Retinal fundus photograph — 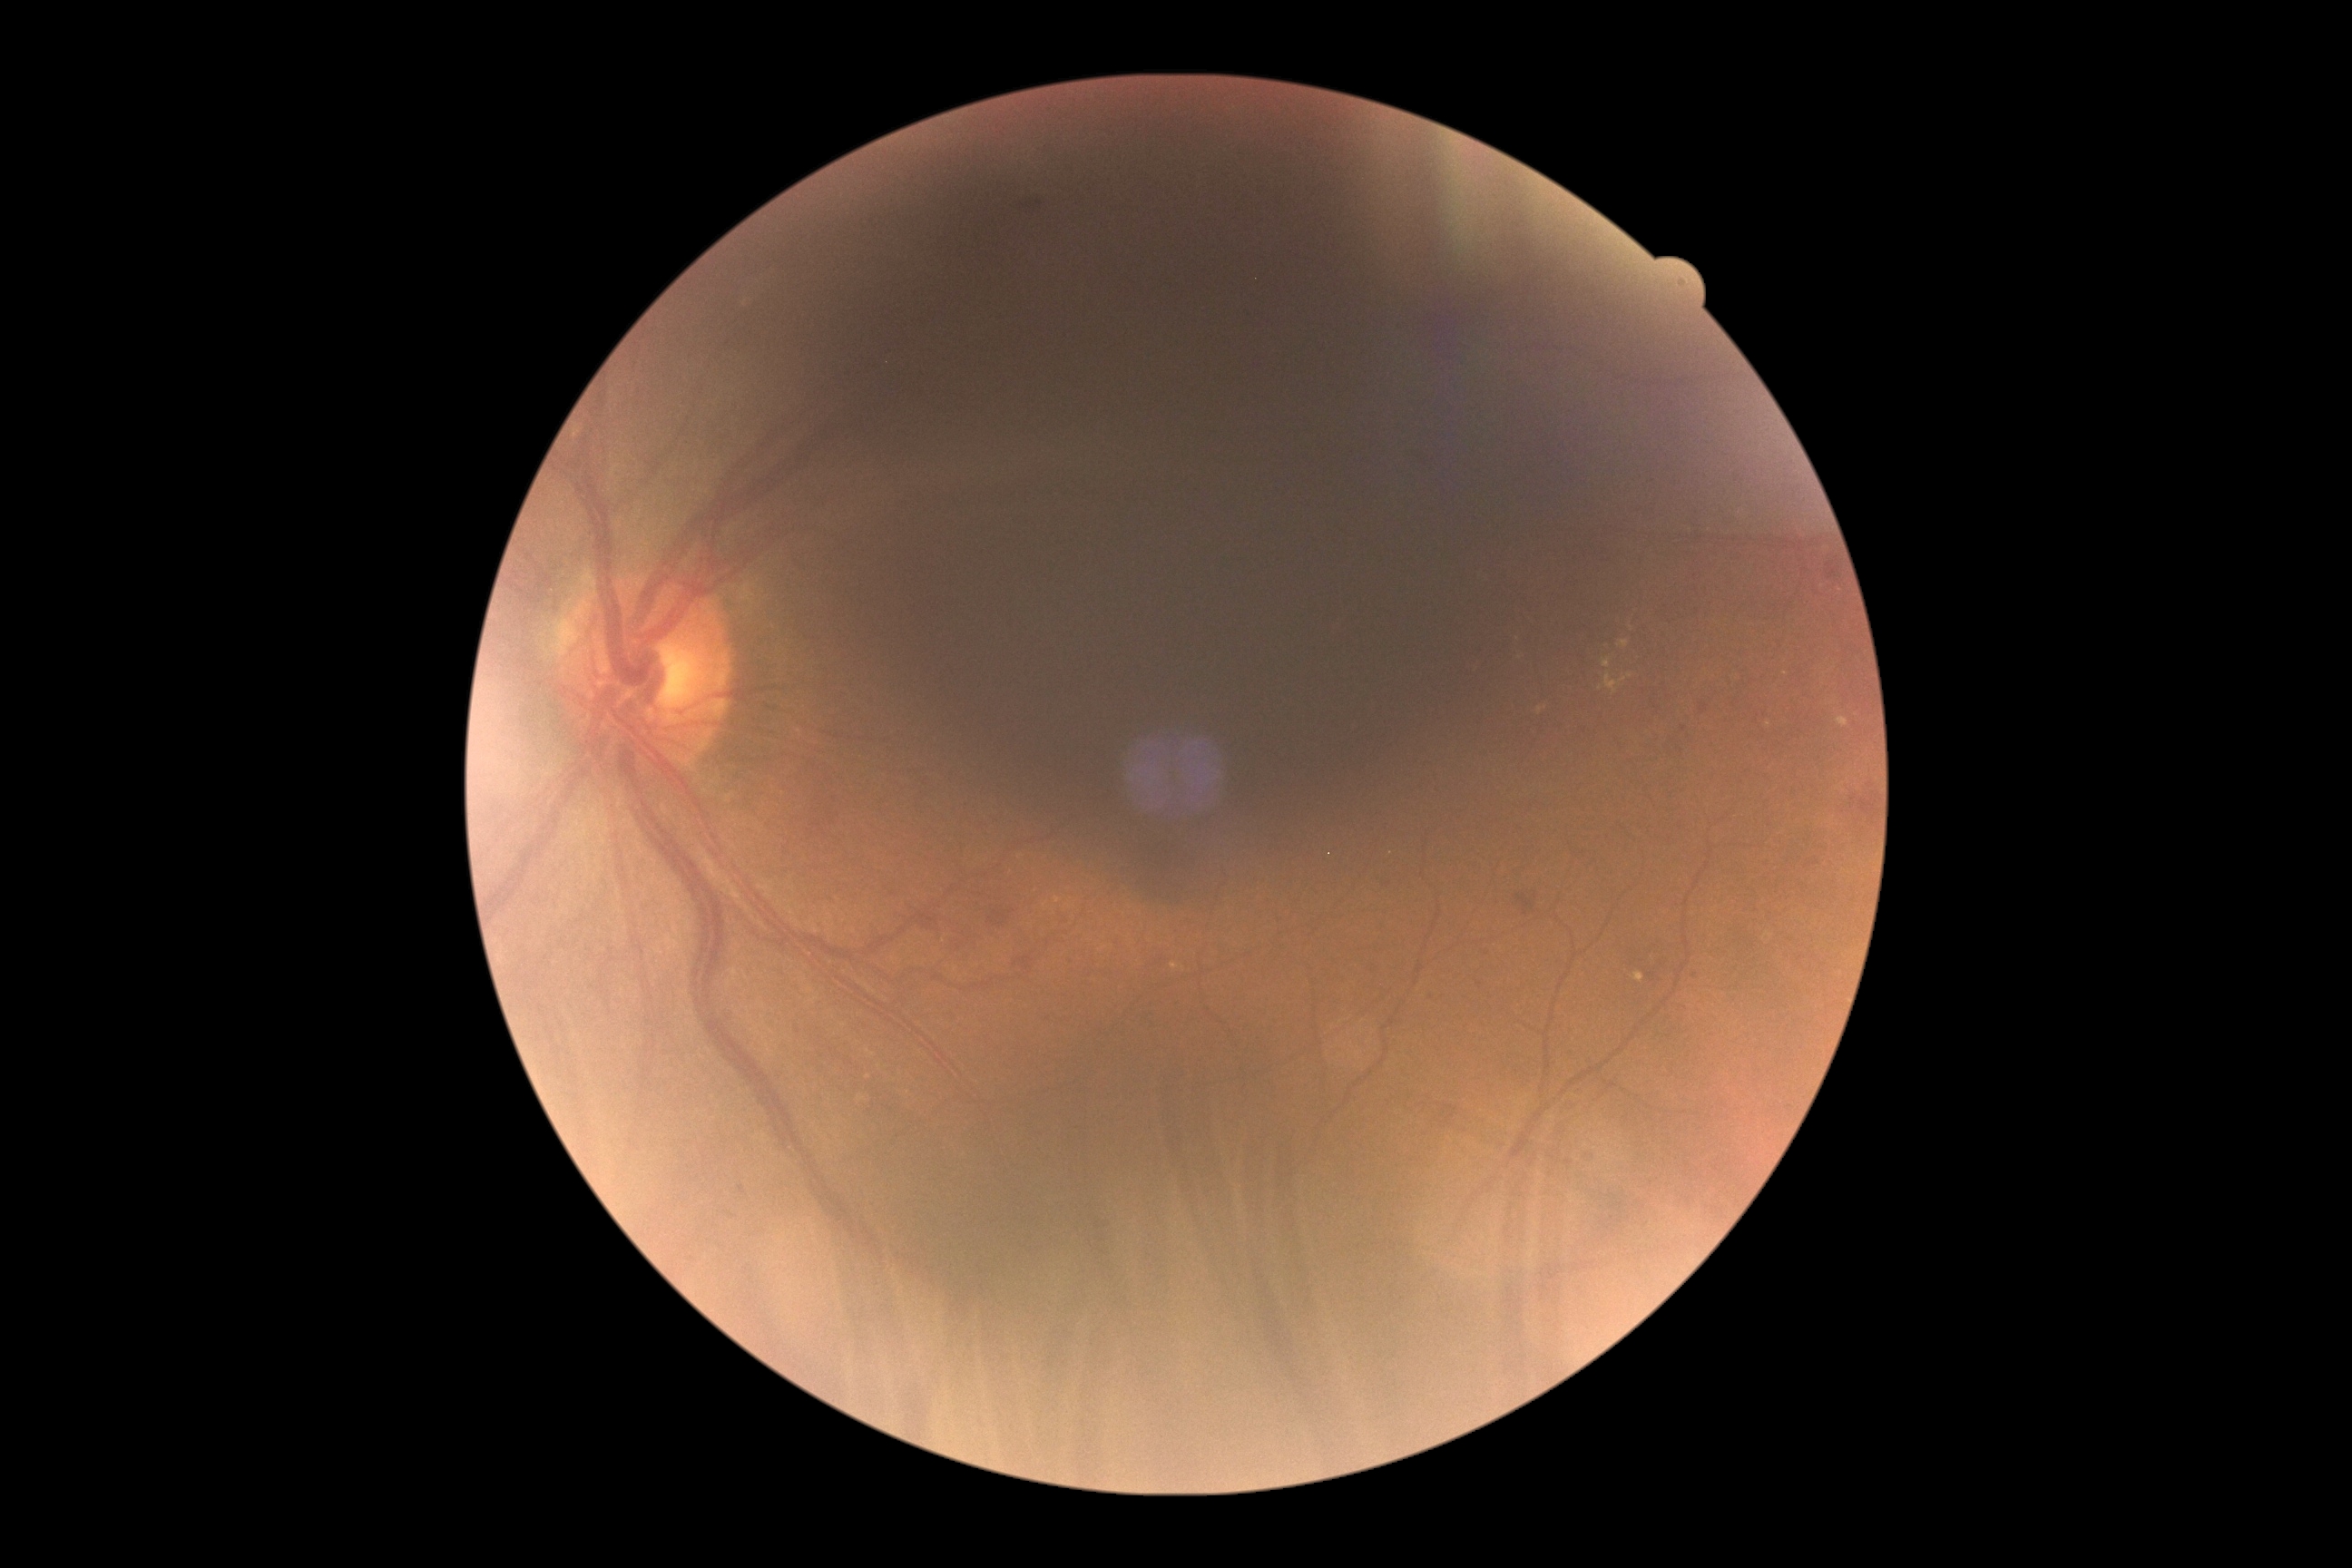 Retinopathy is 2/4.